Acquired on the Natus RetCam Envision; 1440x1080px; RetCam wide-field infant fundus image — 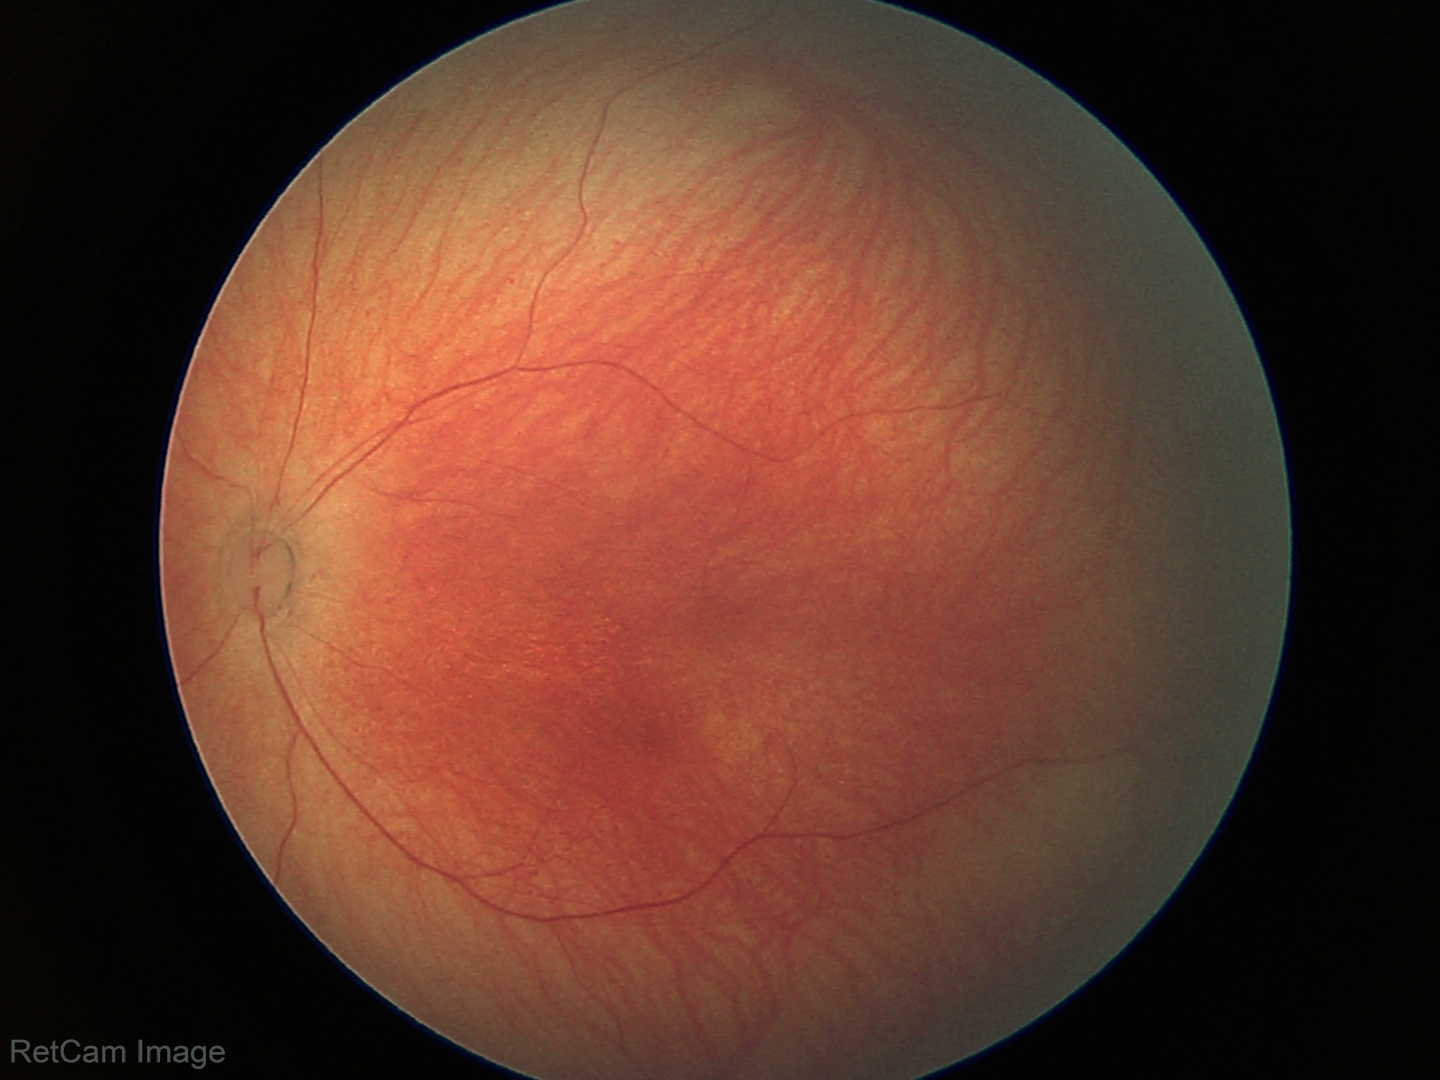
Examination with physiological retinal findings.